45-degree field of view. 2212x1659. Retinal fundus photograph:
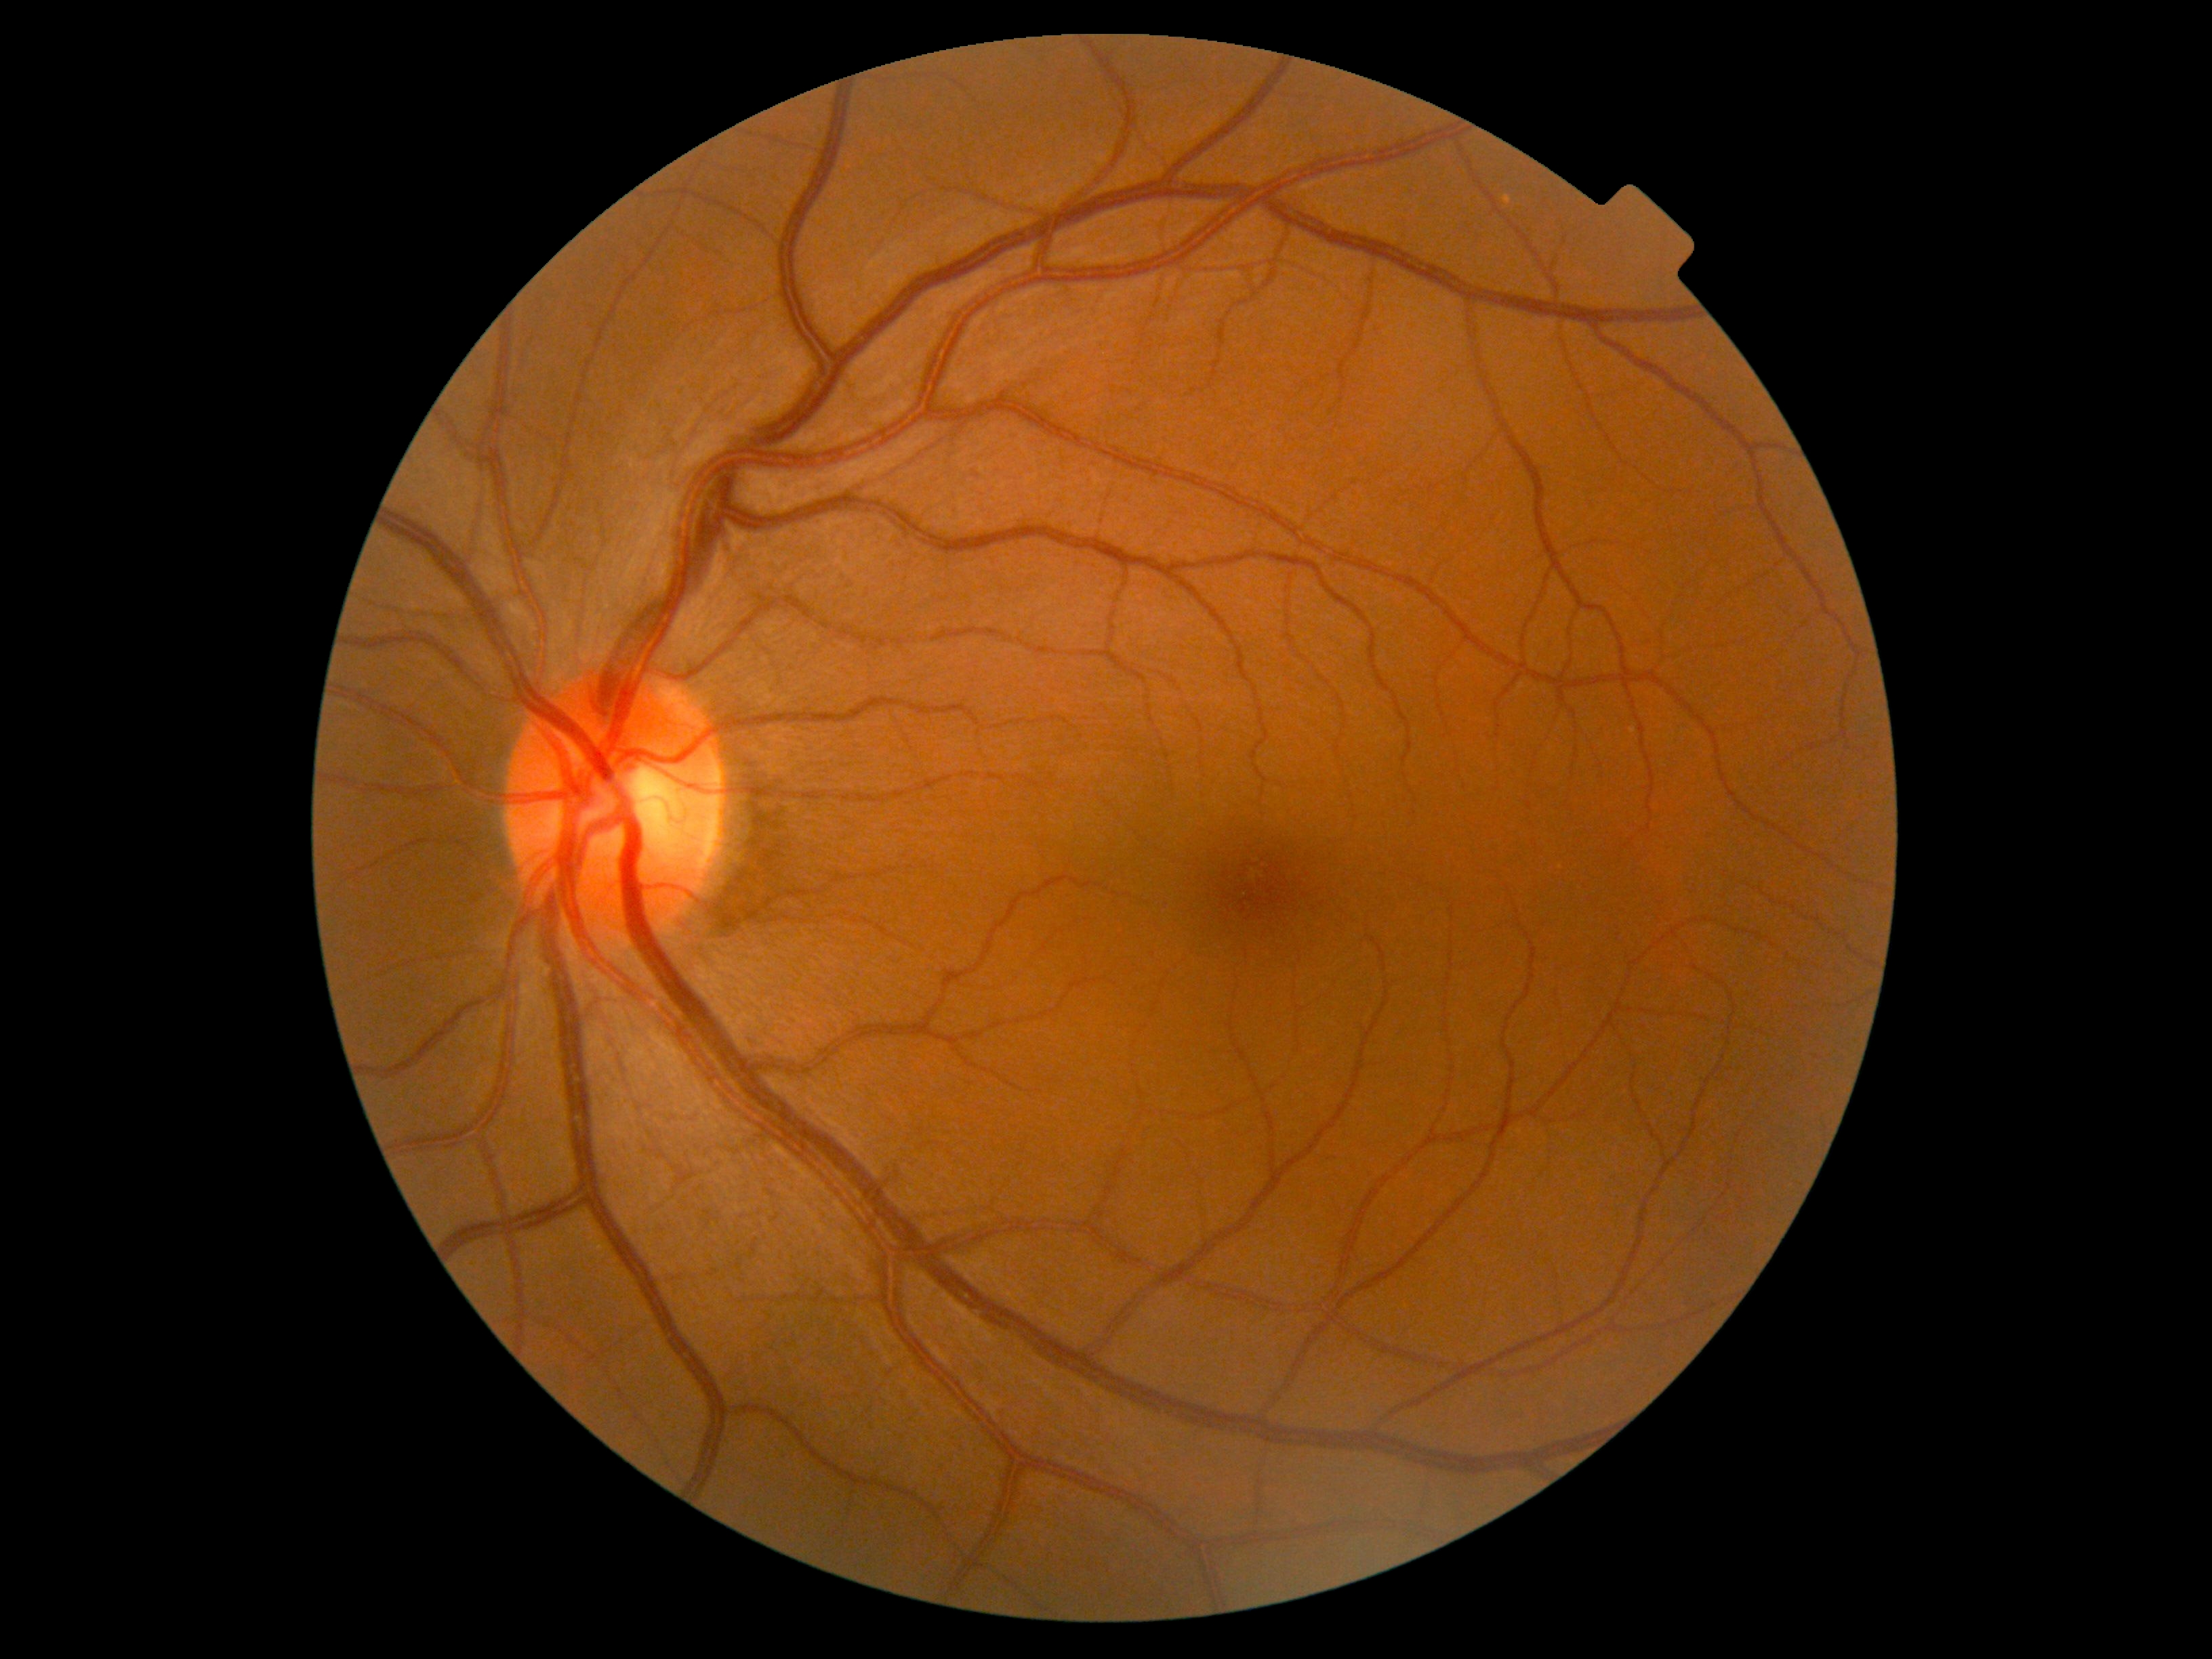
No DR findings. DR stage: 0/4 — no visible signs of diabetic retinopathy.